Modified Davis classification: 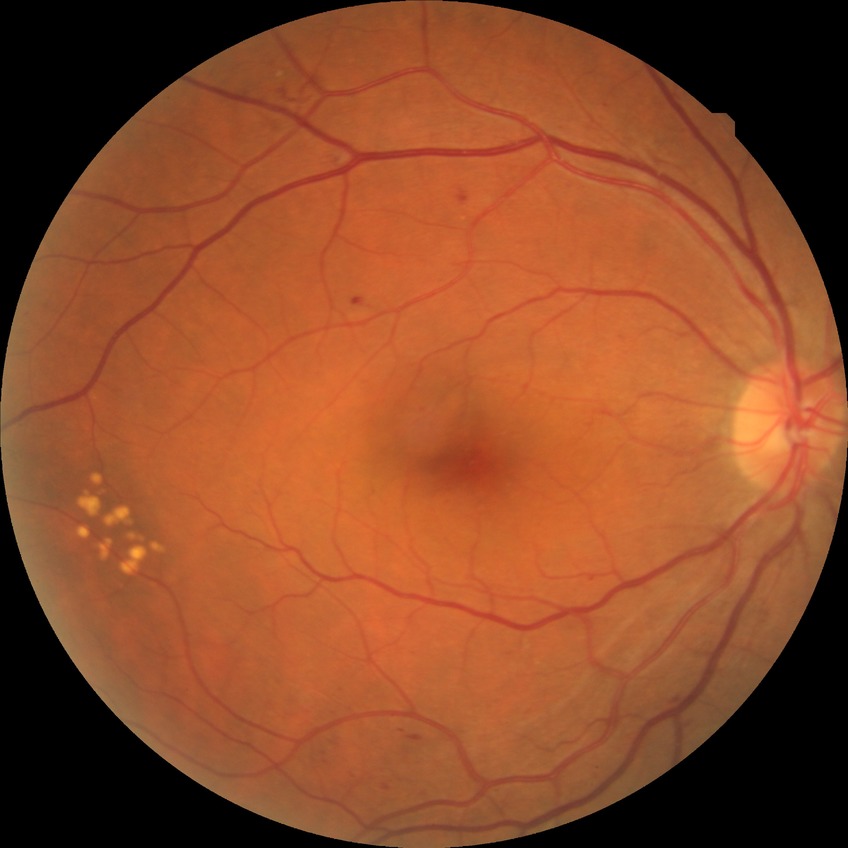
diabetic retinopathy (DR): pre-proliferative diabetic retinopathy (PPDR).